1932 x 1910 pixels:
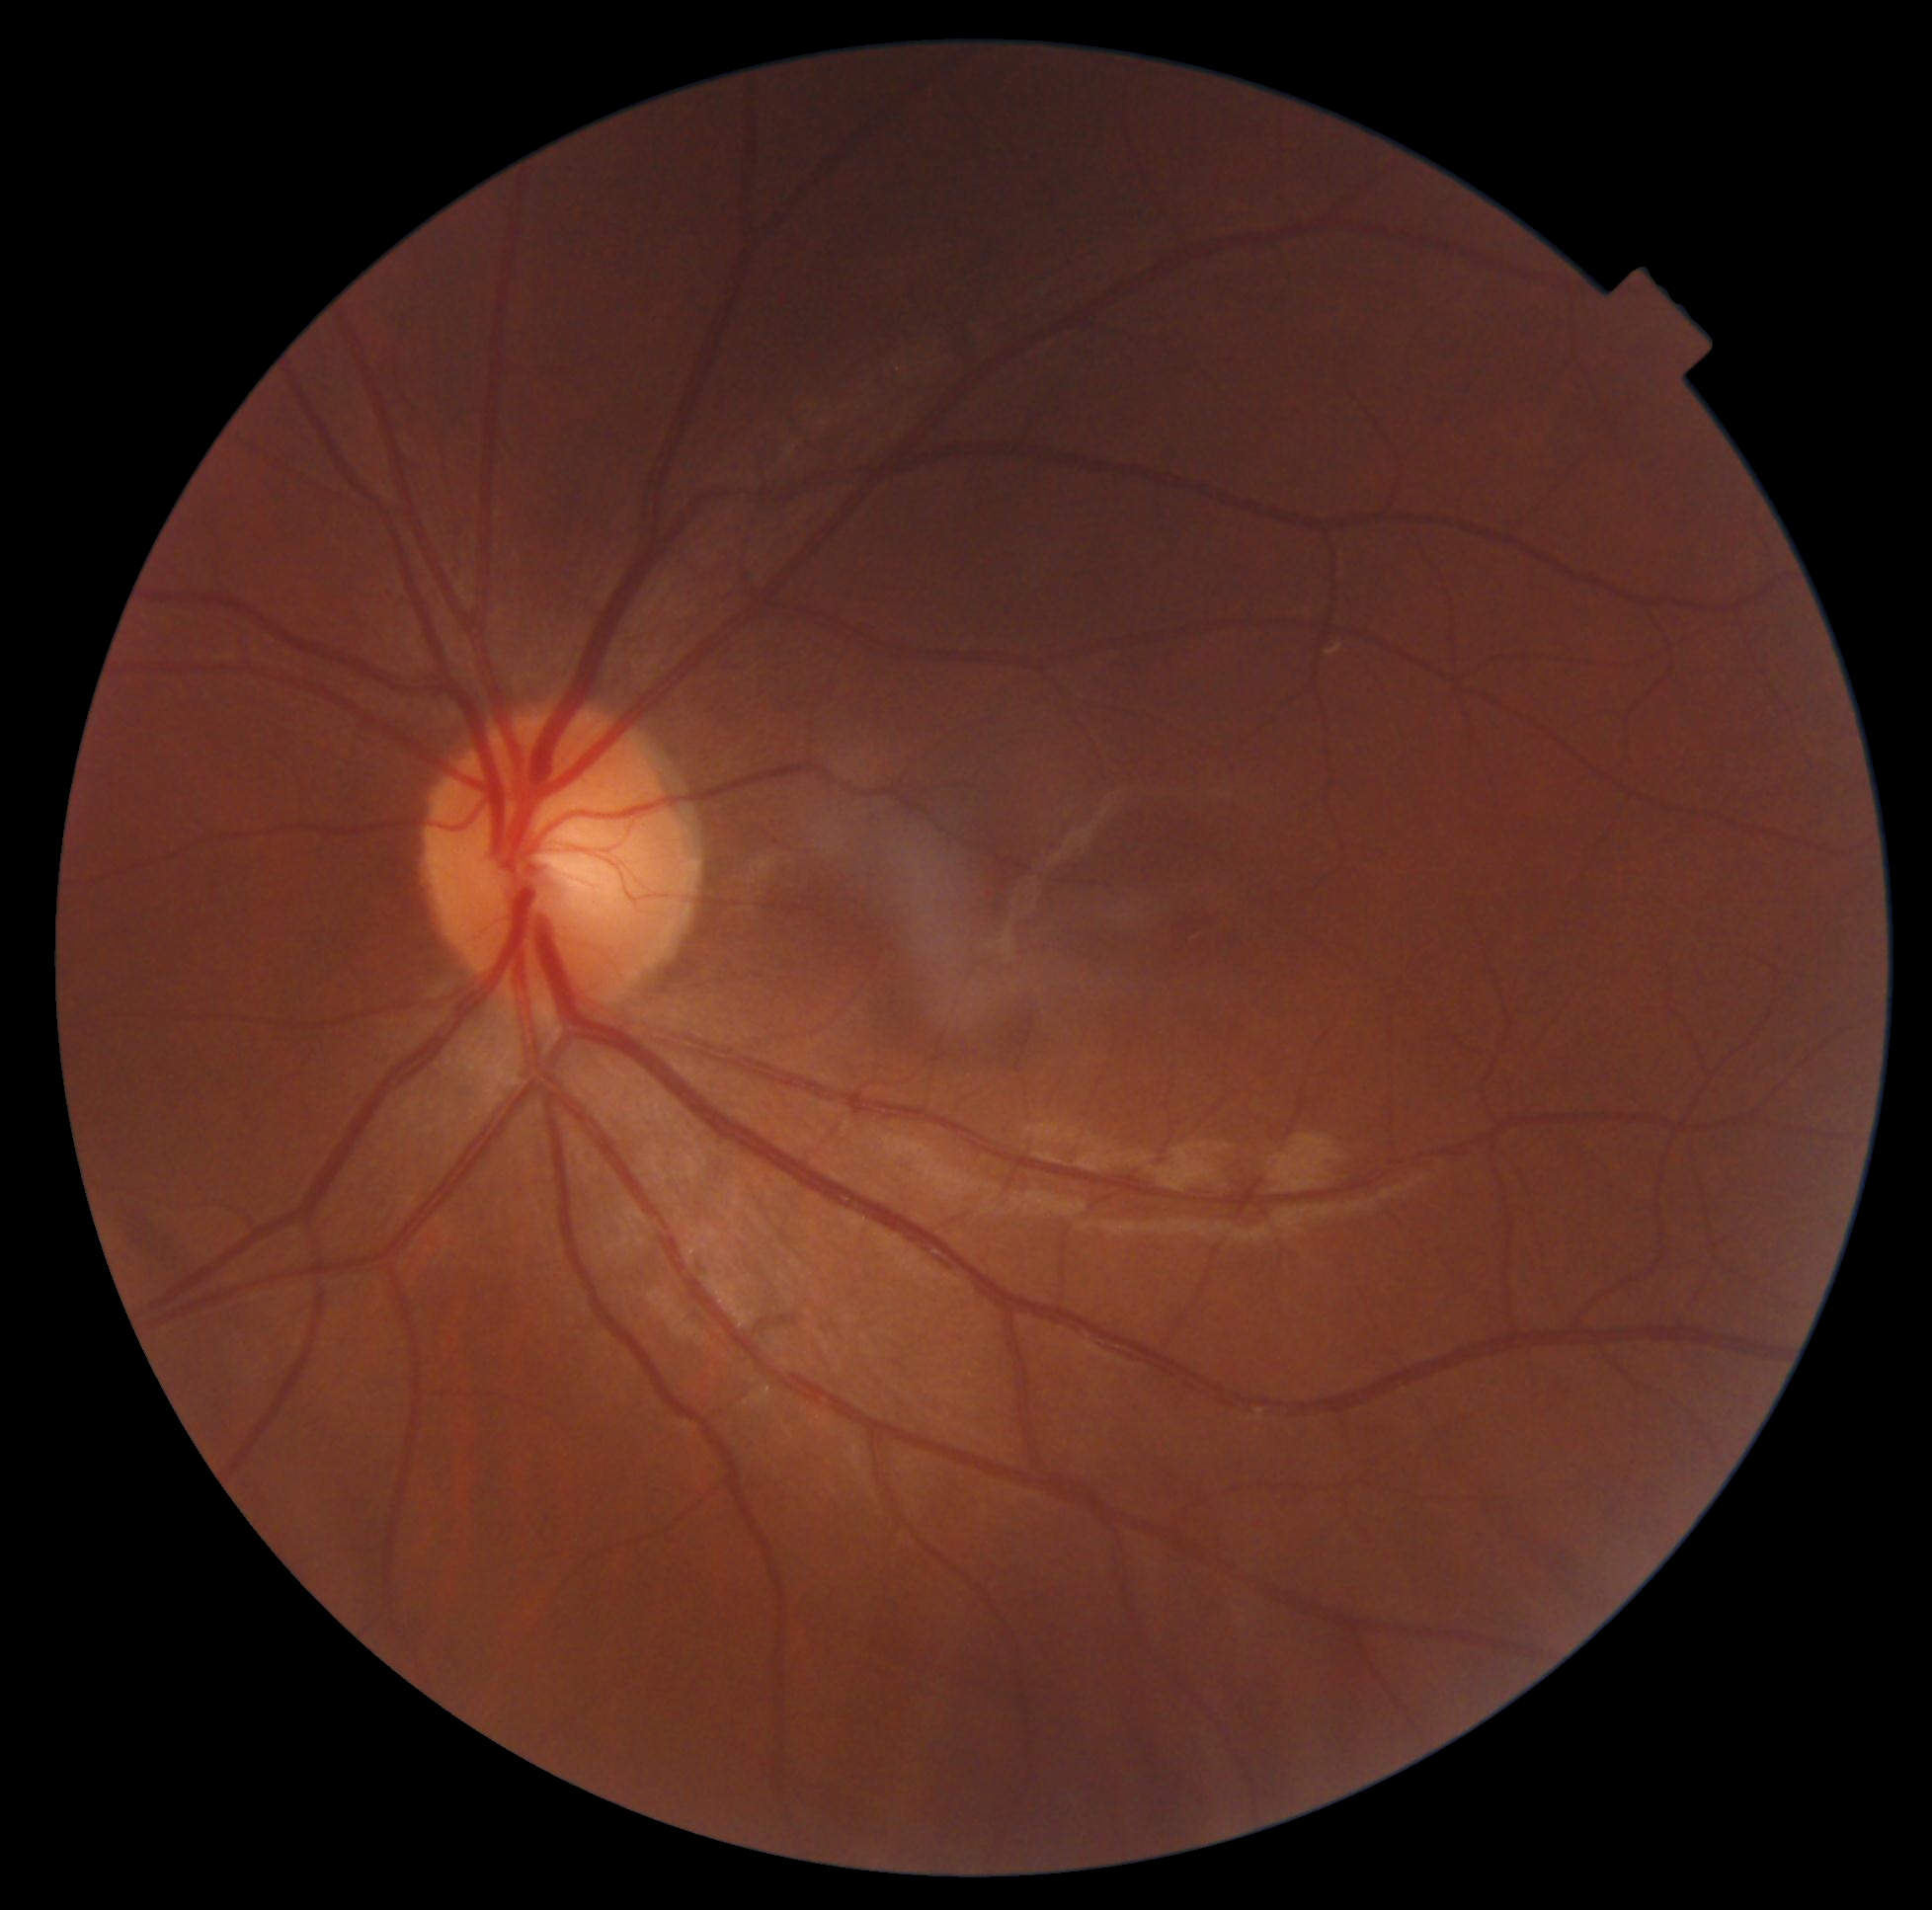
Retinopathy: 0.